FOV: 45 degrees · 2048x1536
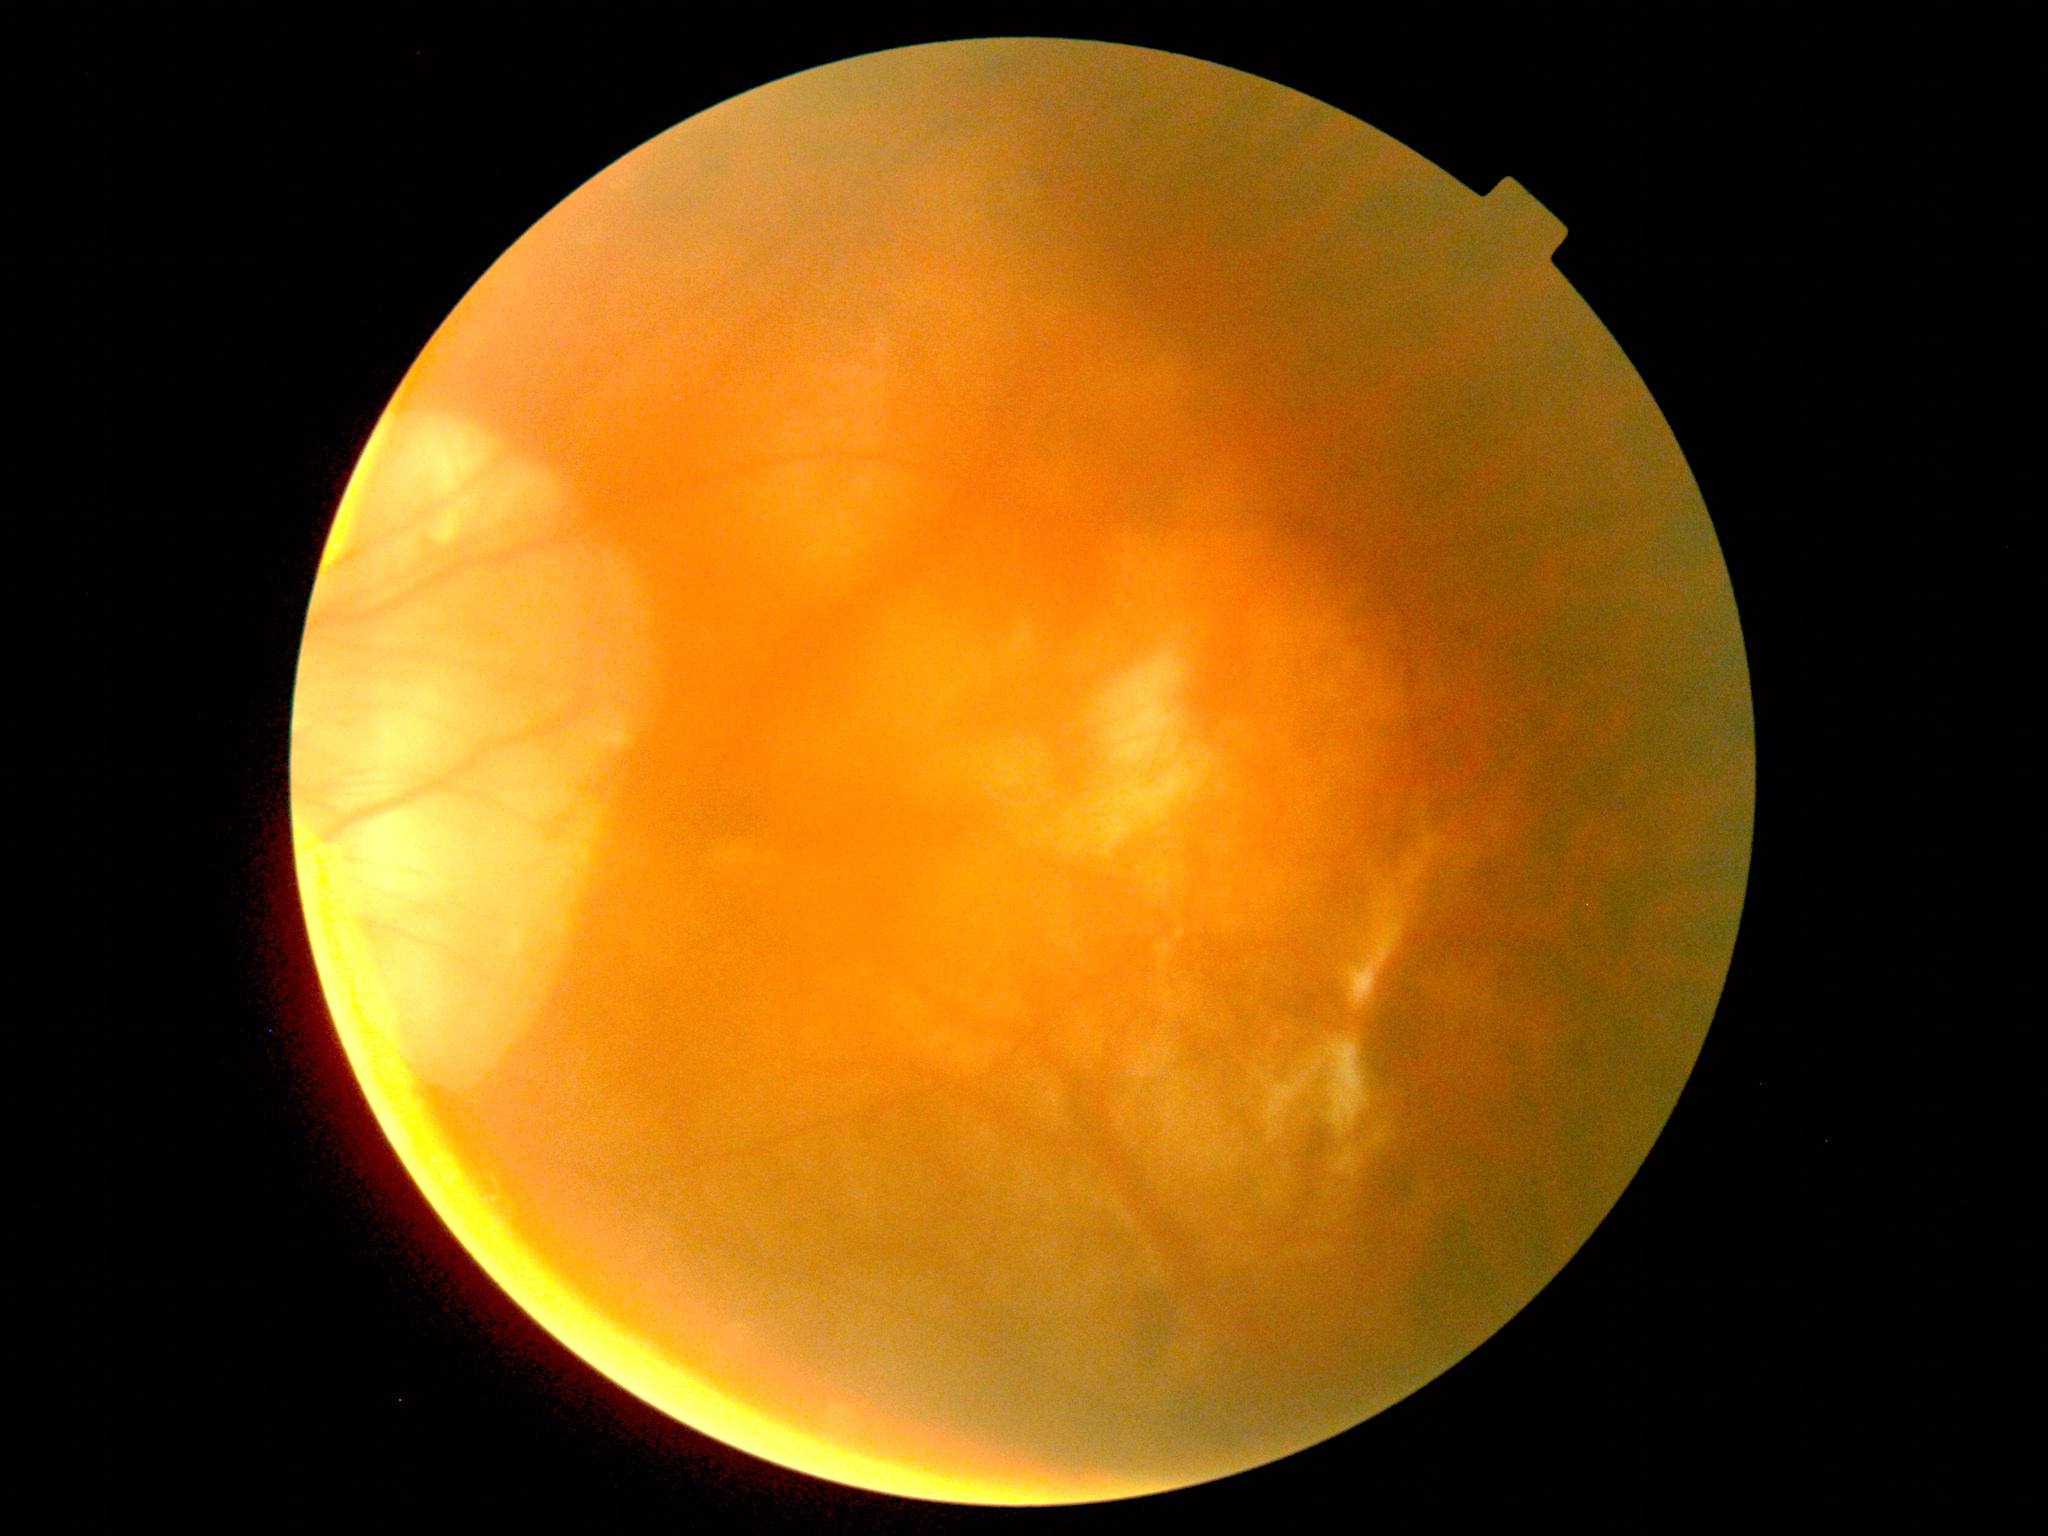
Annotations:
- image quality — insufficient
- retinopathy grade — ungradable due to poor image quality